Without pupil dilation
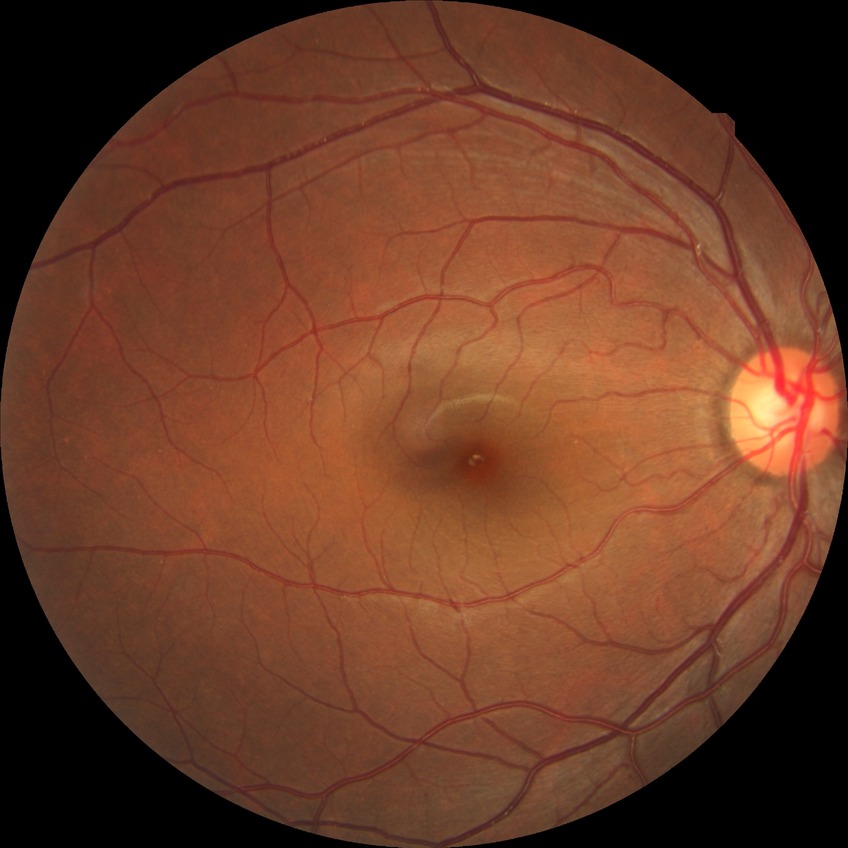
Retinopathy grade: no diabetic retinopathy.